2089x1764px: 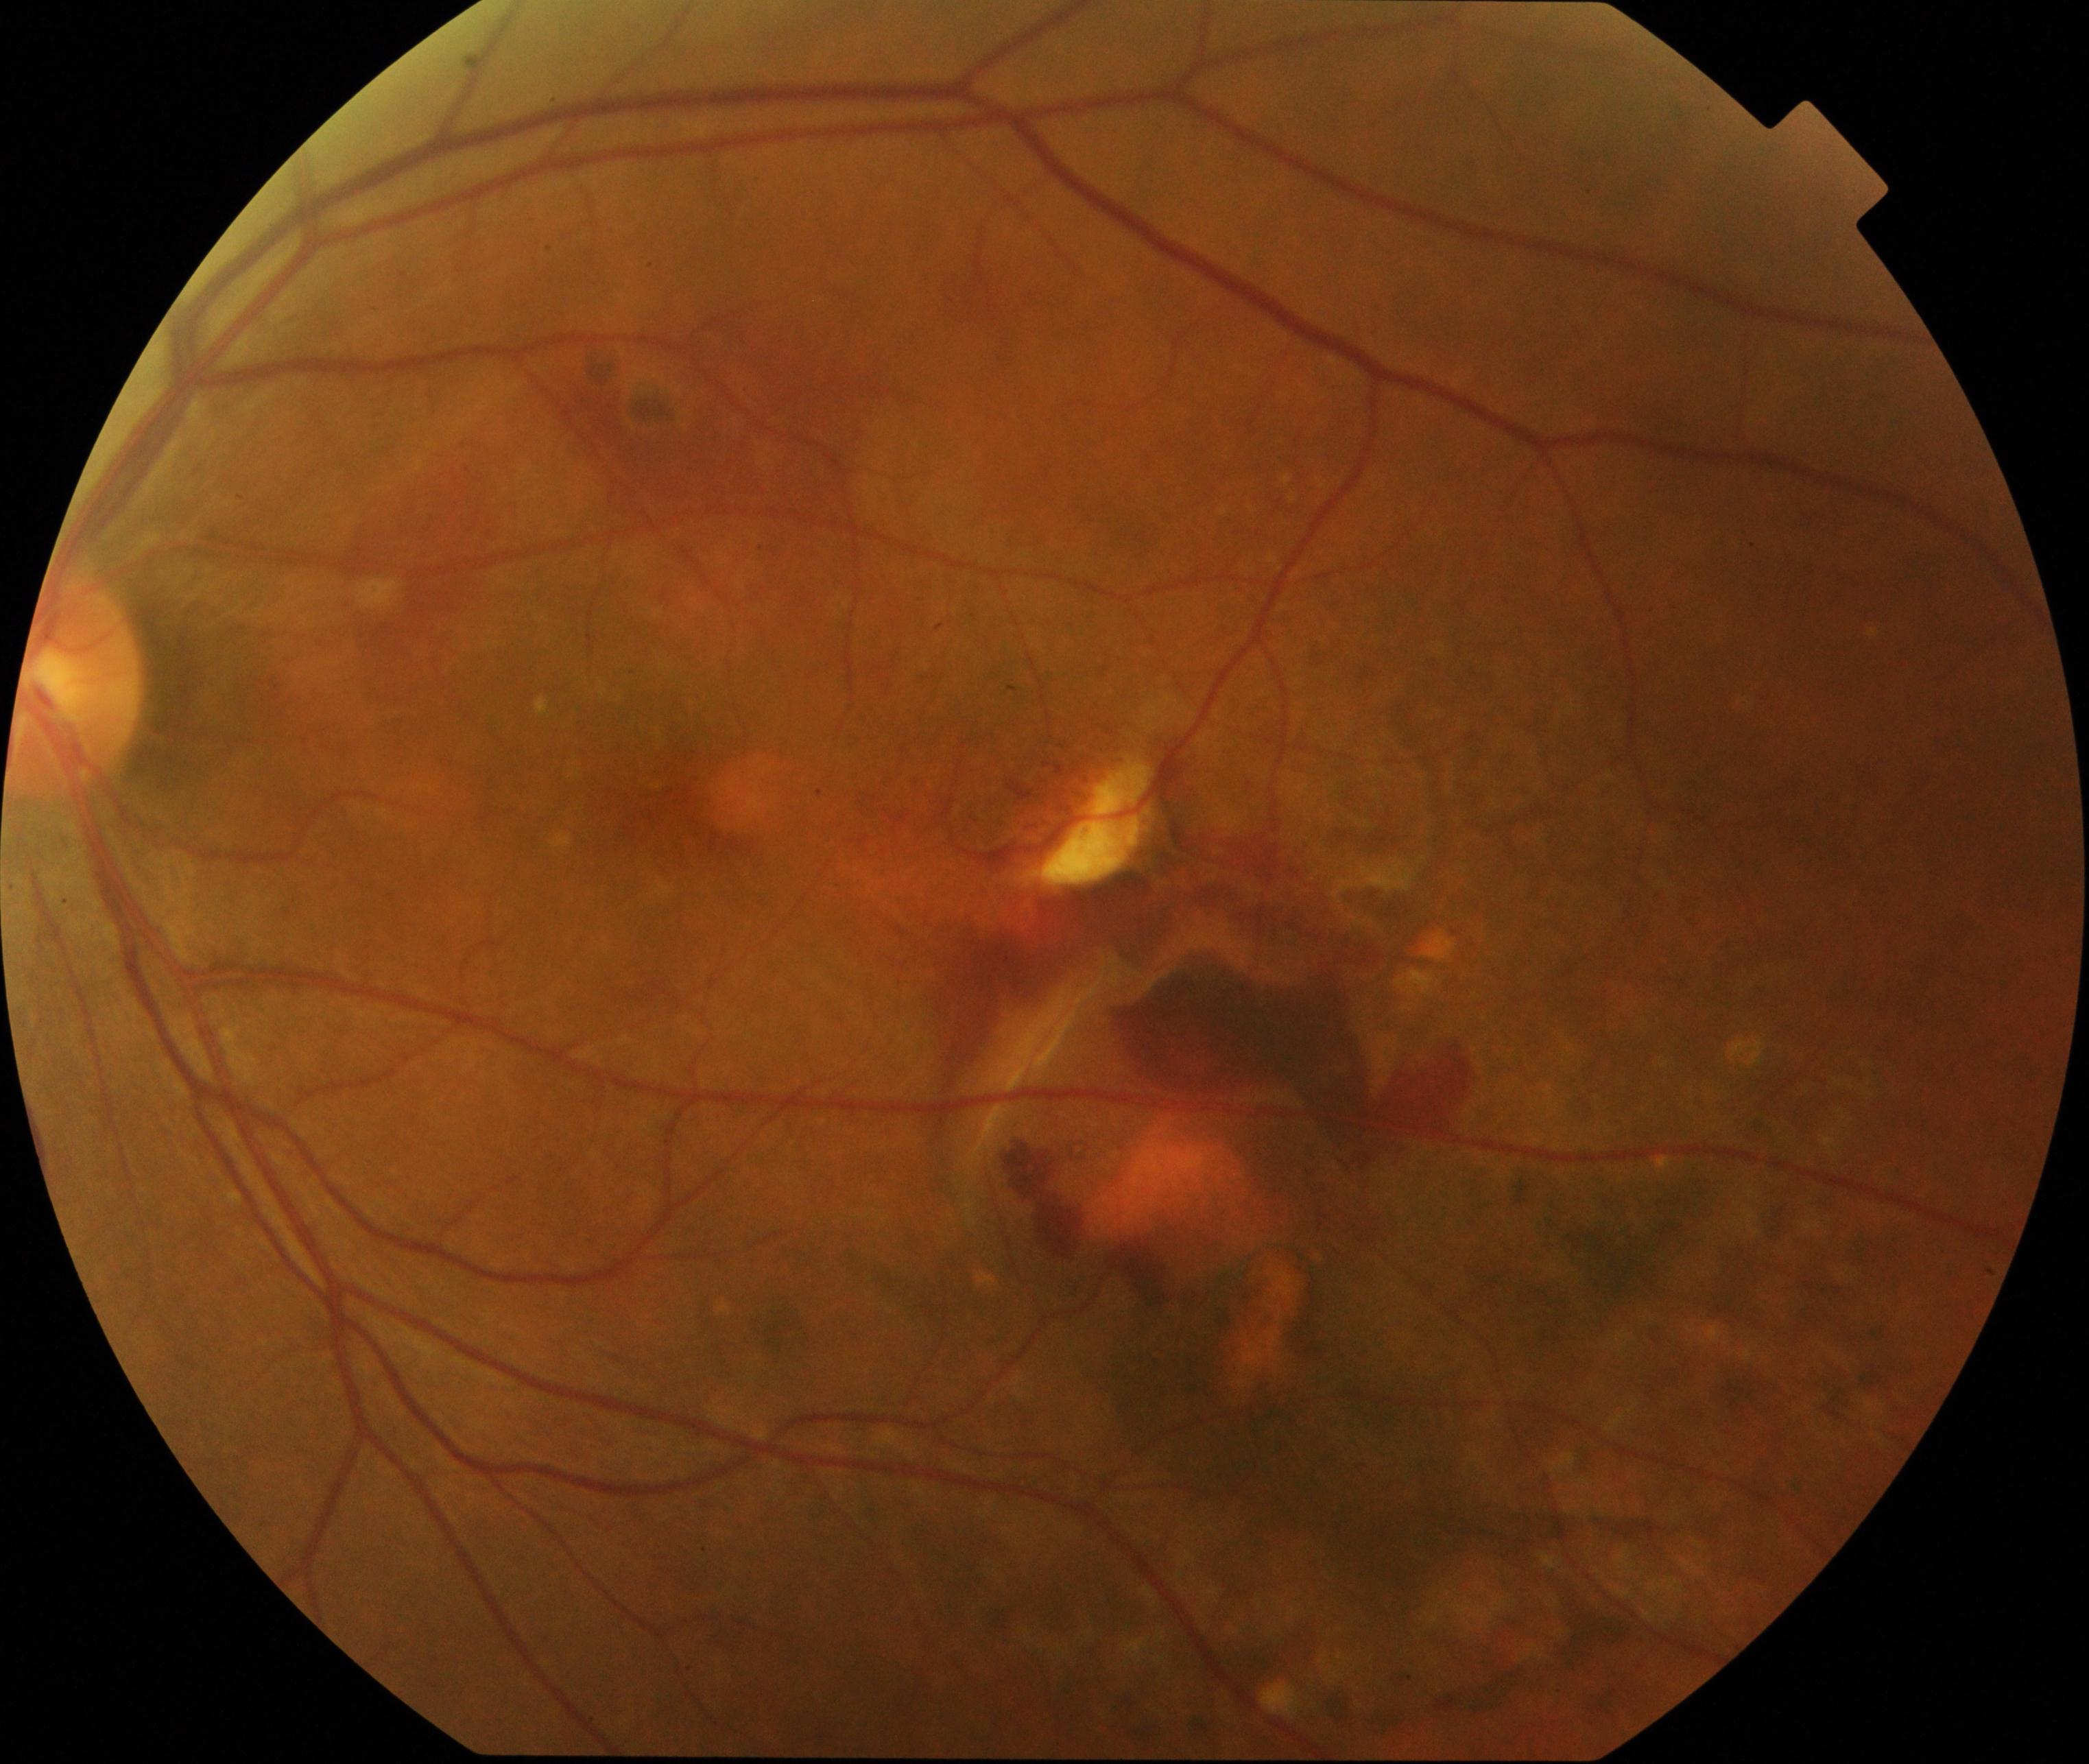

Findings consistent with maculopathy.